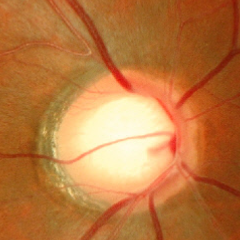 Q: Is glaucoma present?
A: Yes — early glaucoma.